Phoenix ICON wide-field infant fundus image. Camera: Phoenix ICON (100° FOV). 1240 by 1240 pixels.
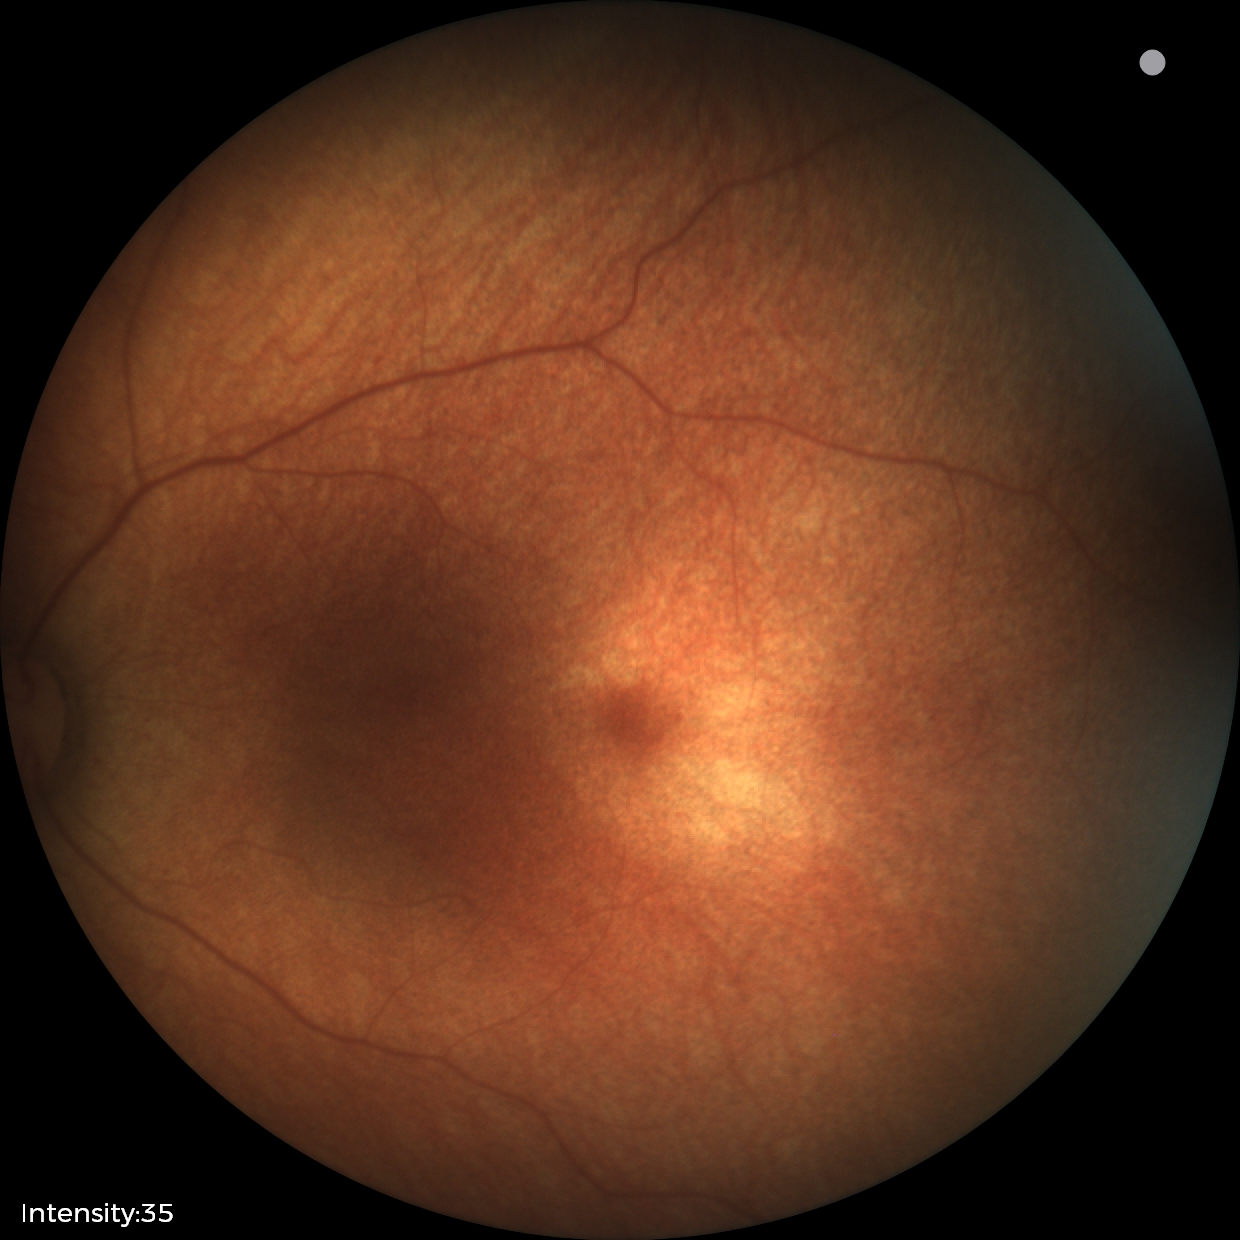
Physiological retinal appearance for postconceptual age.